DR severity per modified Davis staging — 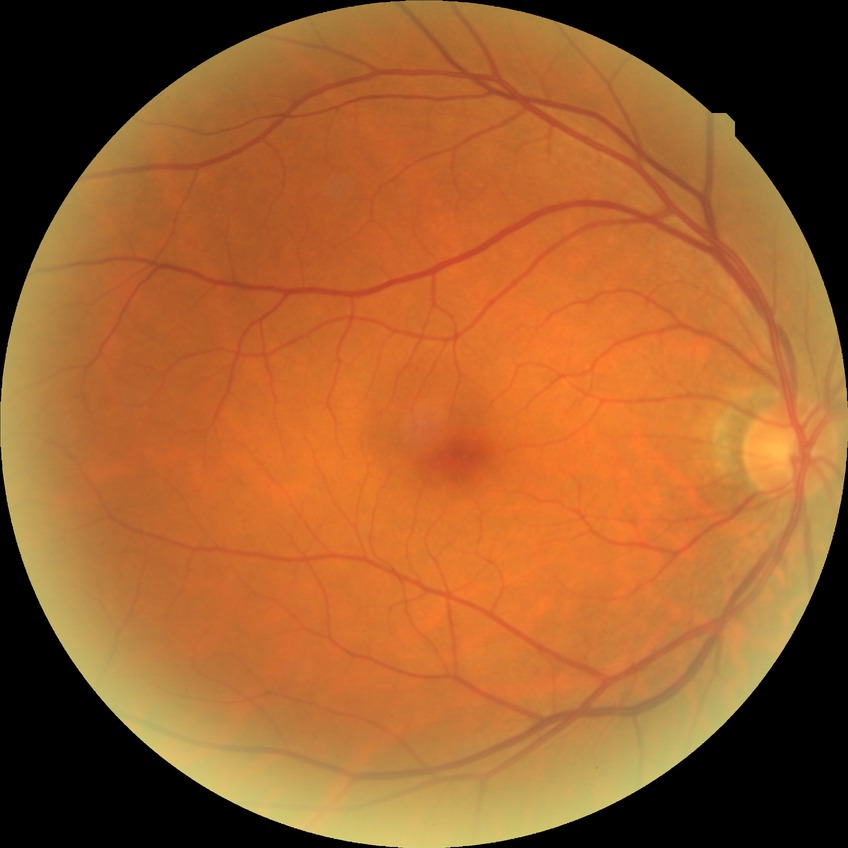
diabetic retinopathy (DR)=no diabetic retinopathy (NDR).